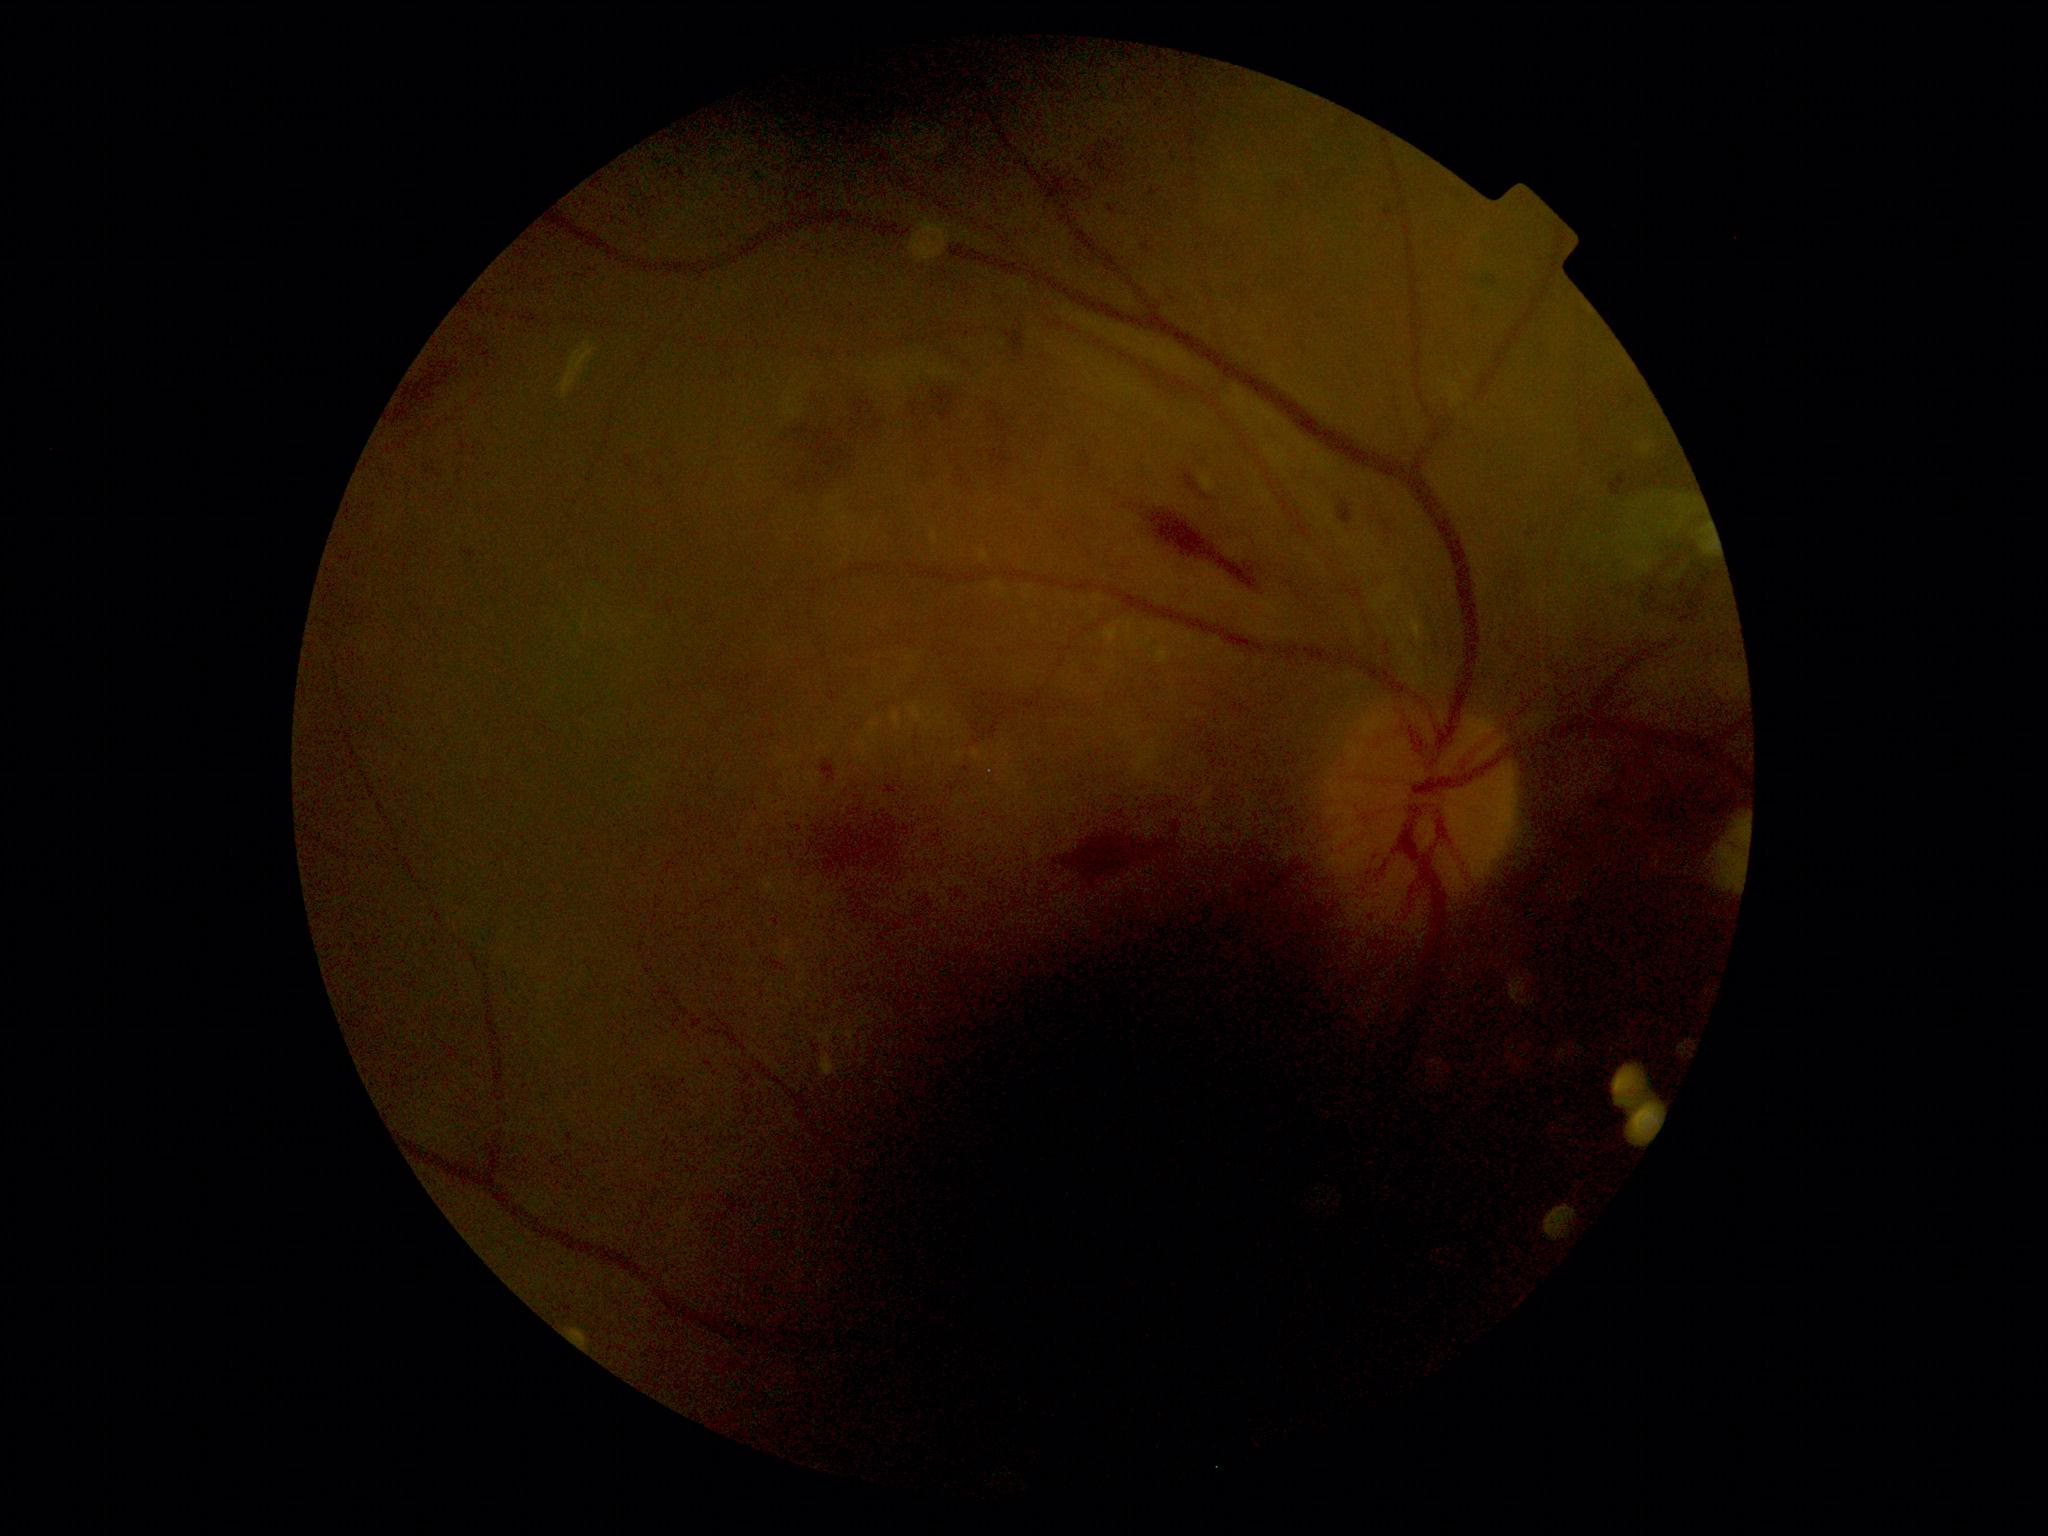
Annotations:
* diabetic retinopathy (DR) — grade 2